Infant wide-field retinal image. 1240 by 1240 pixels:
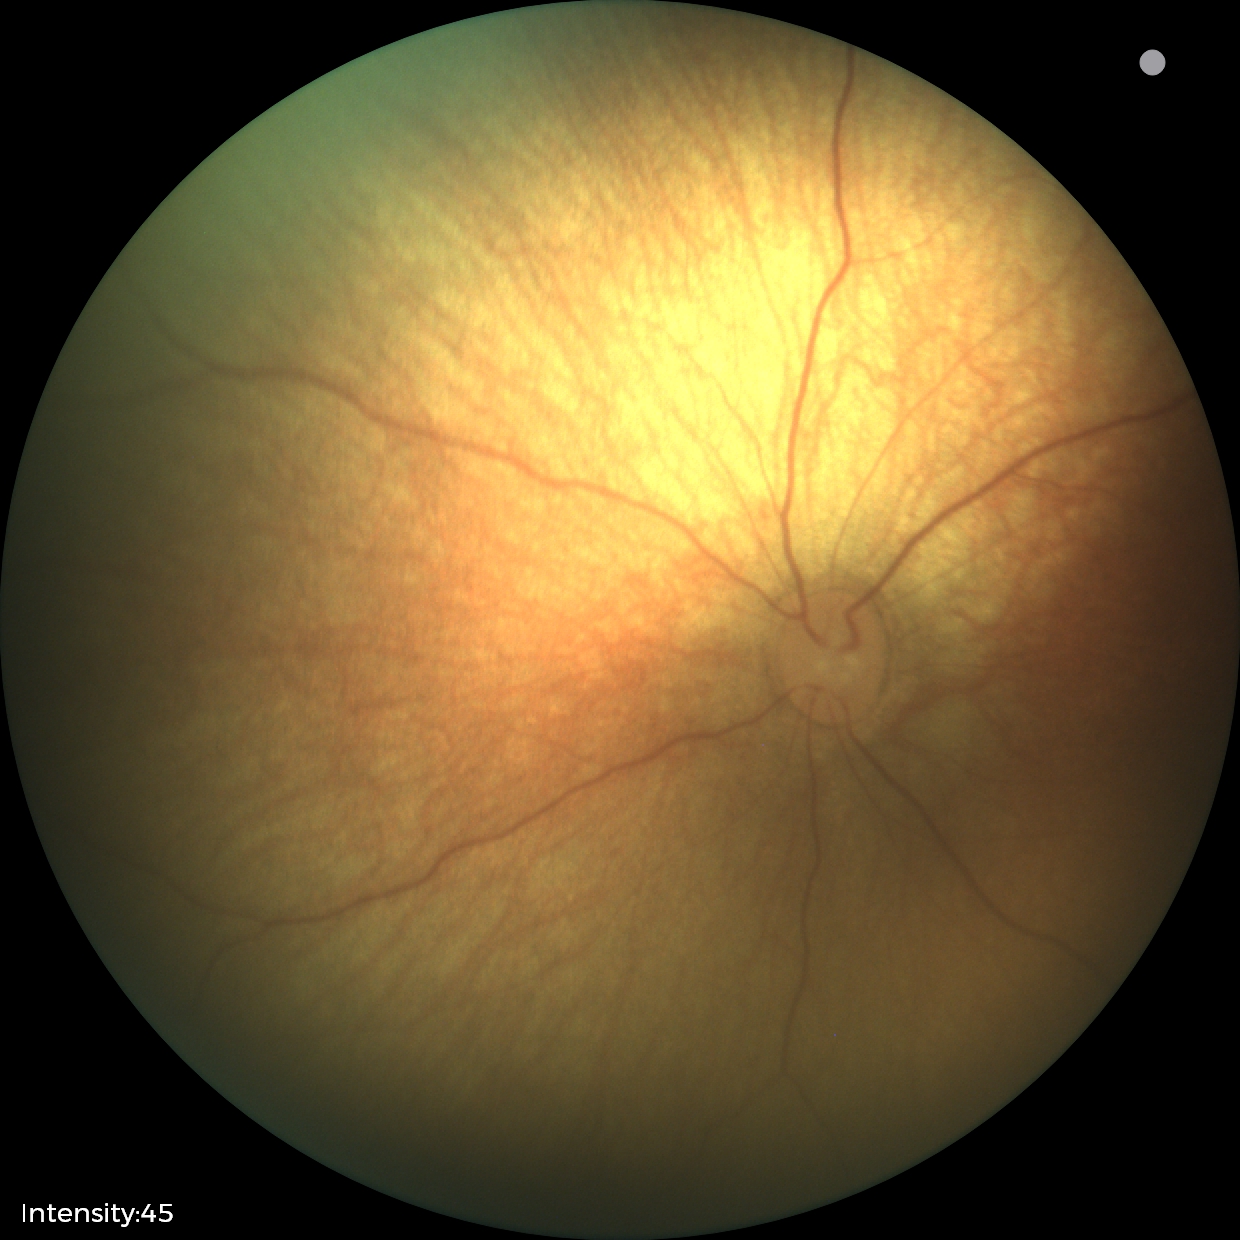
Diagnosis: physiological appearance.